Fundus photo, 2352 x 1568 pixels: 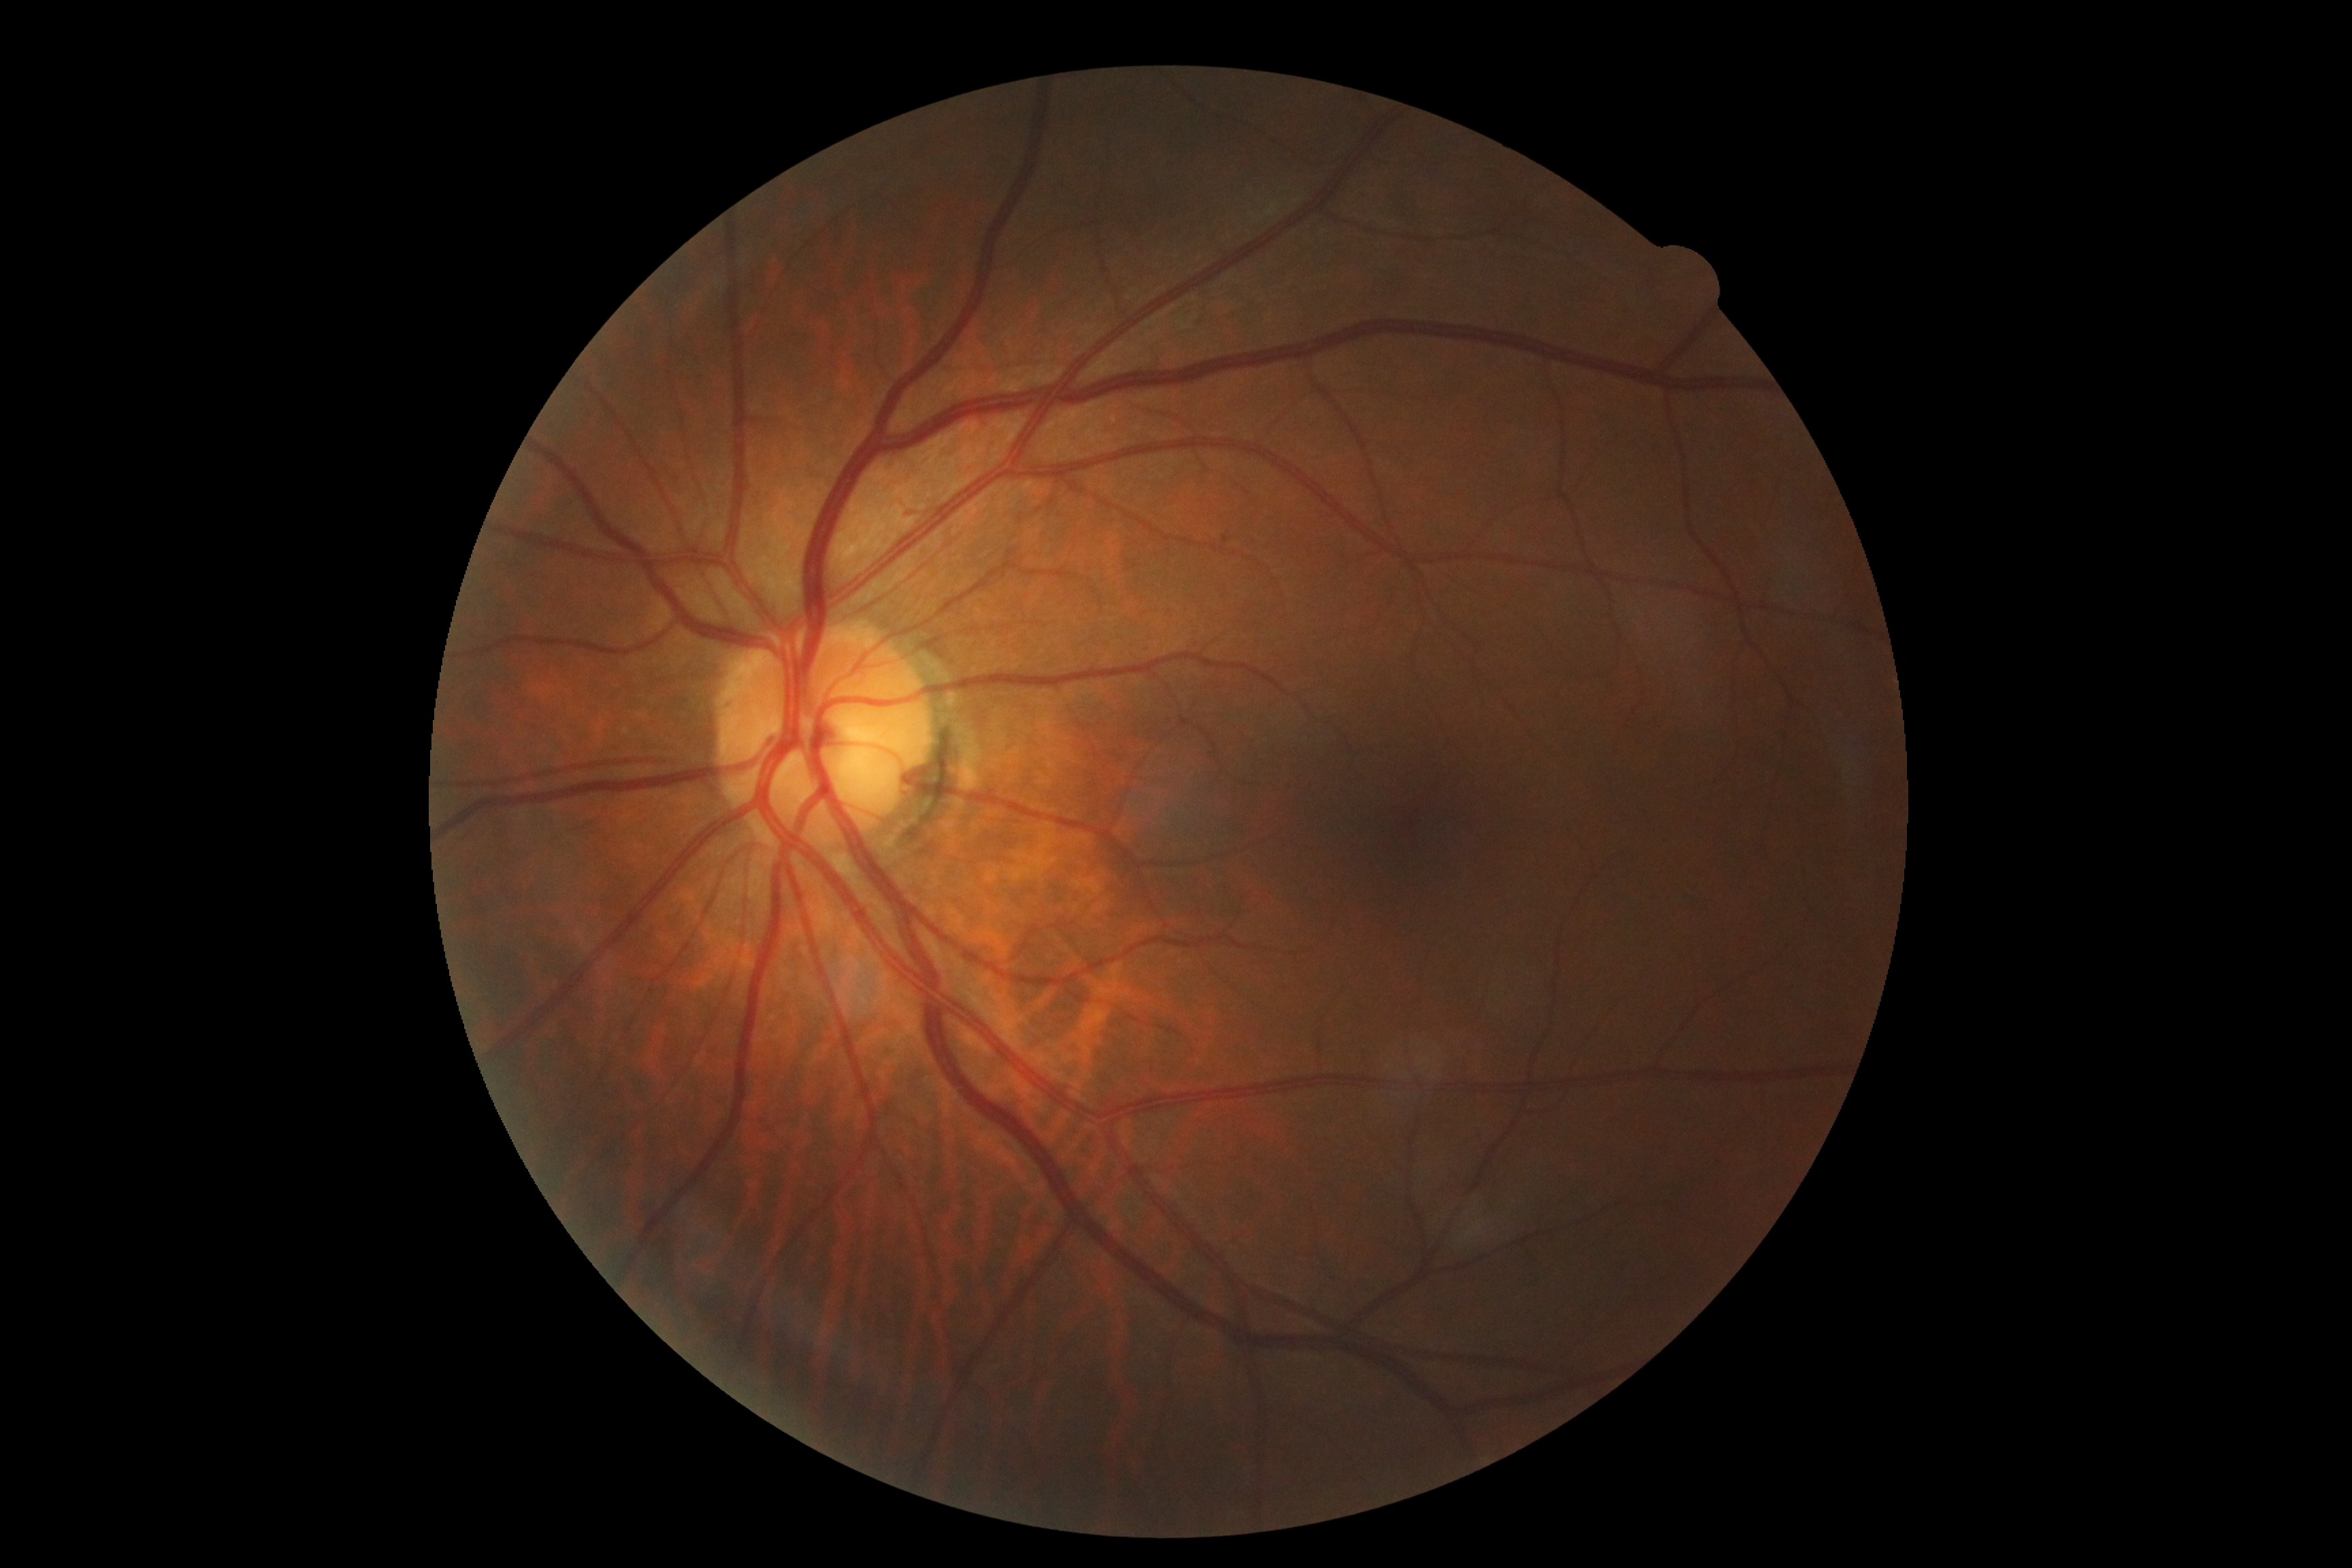

Findings:
• diabetic retinopathy grade: 0 (no apparent retinopathy)